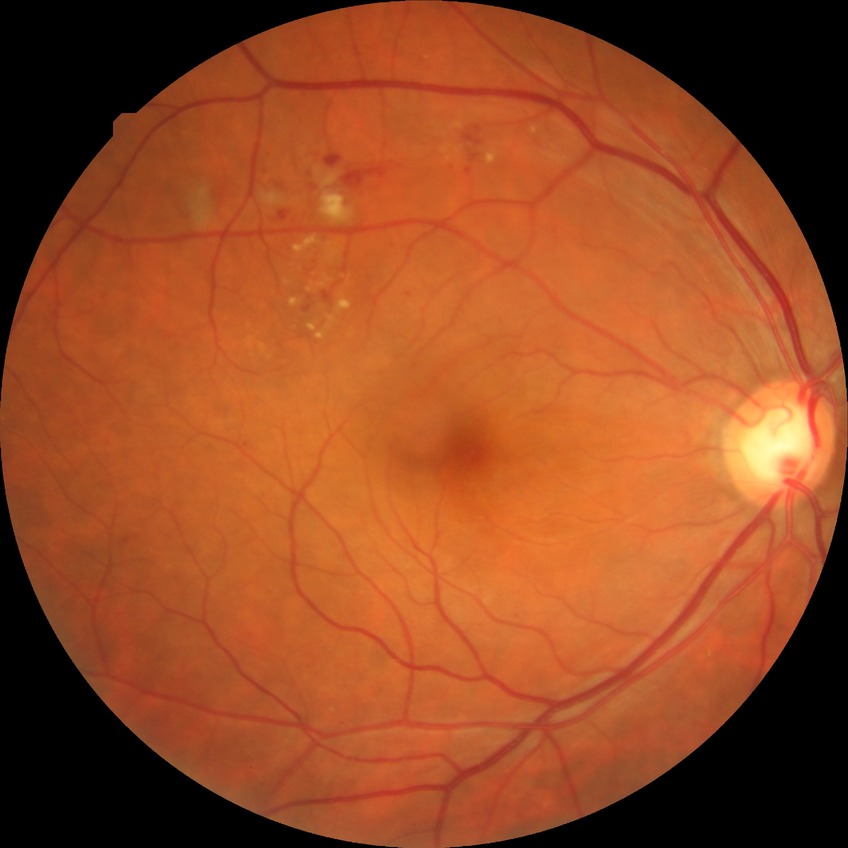

Diabetic retinopathy (DR) is PPDR (pre-proliferative diabetic retinopathy).
Disease class: non-proliferative diabetic retinopathy.